Fundus photo; 45° FOV; 2352 by 1568 pixels: 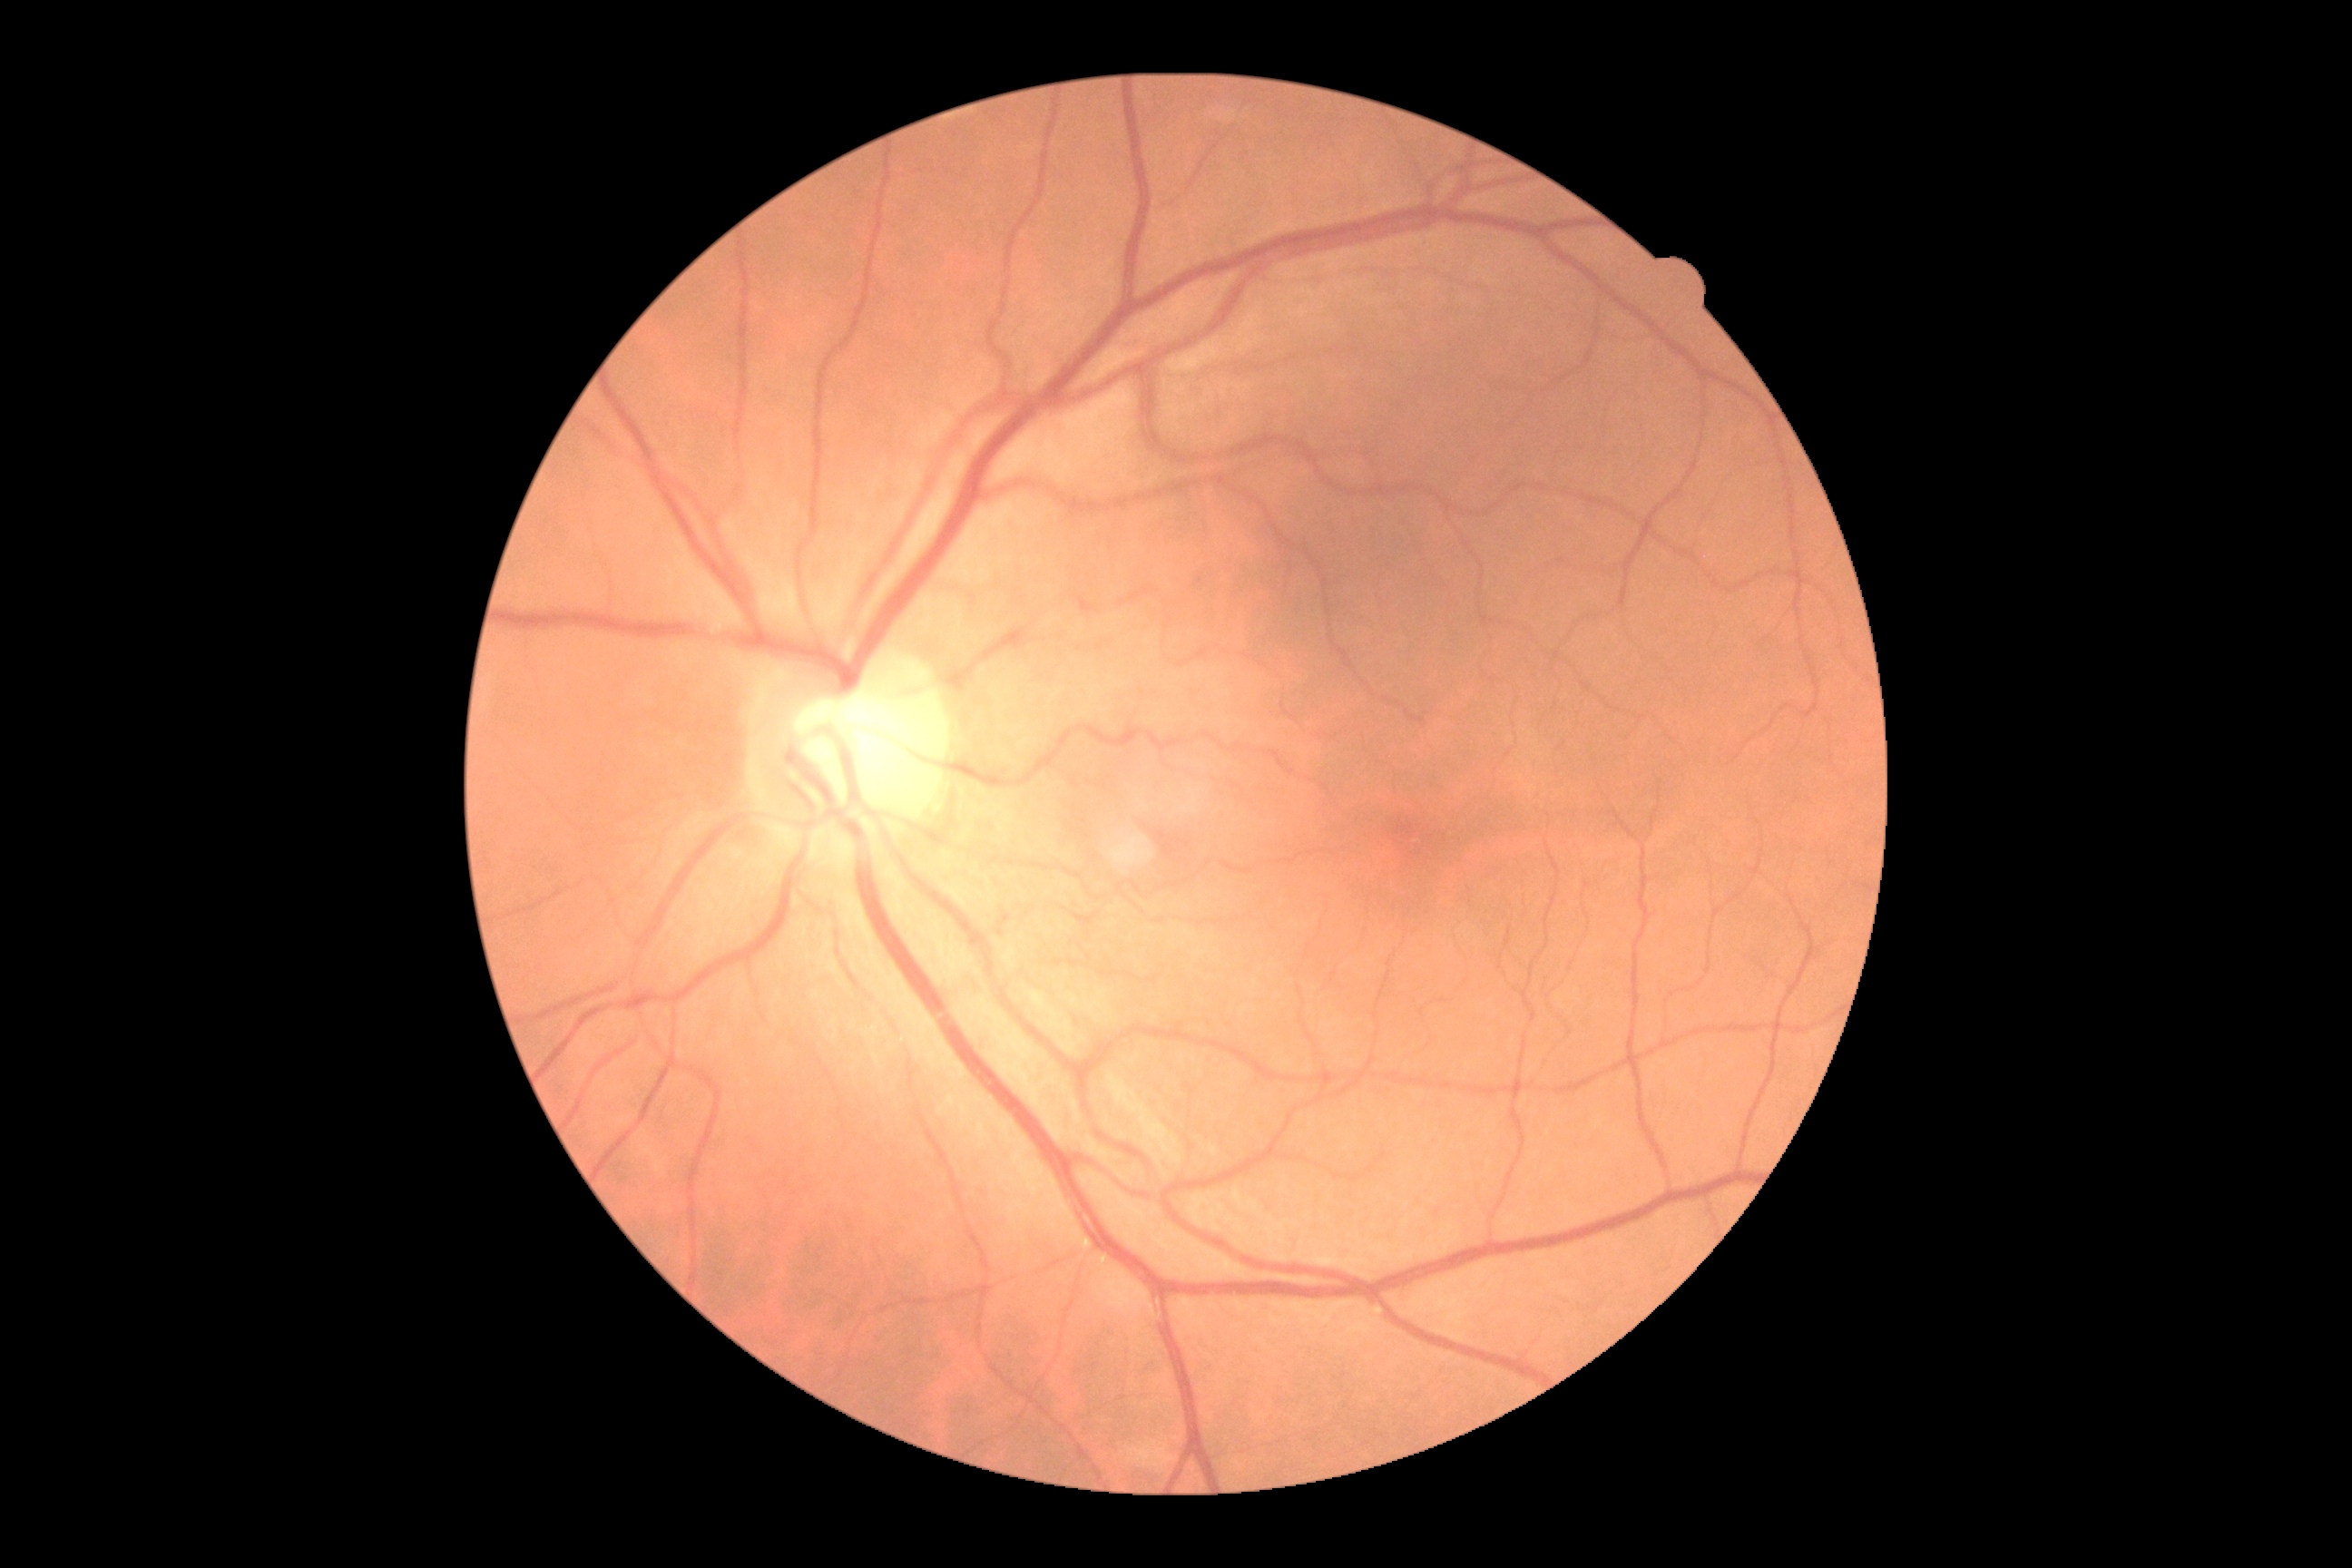 DR is 0/4.